Wide-field fundus photograph from neonatal ROP screening.
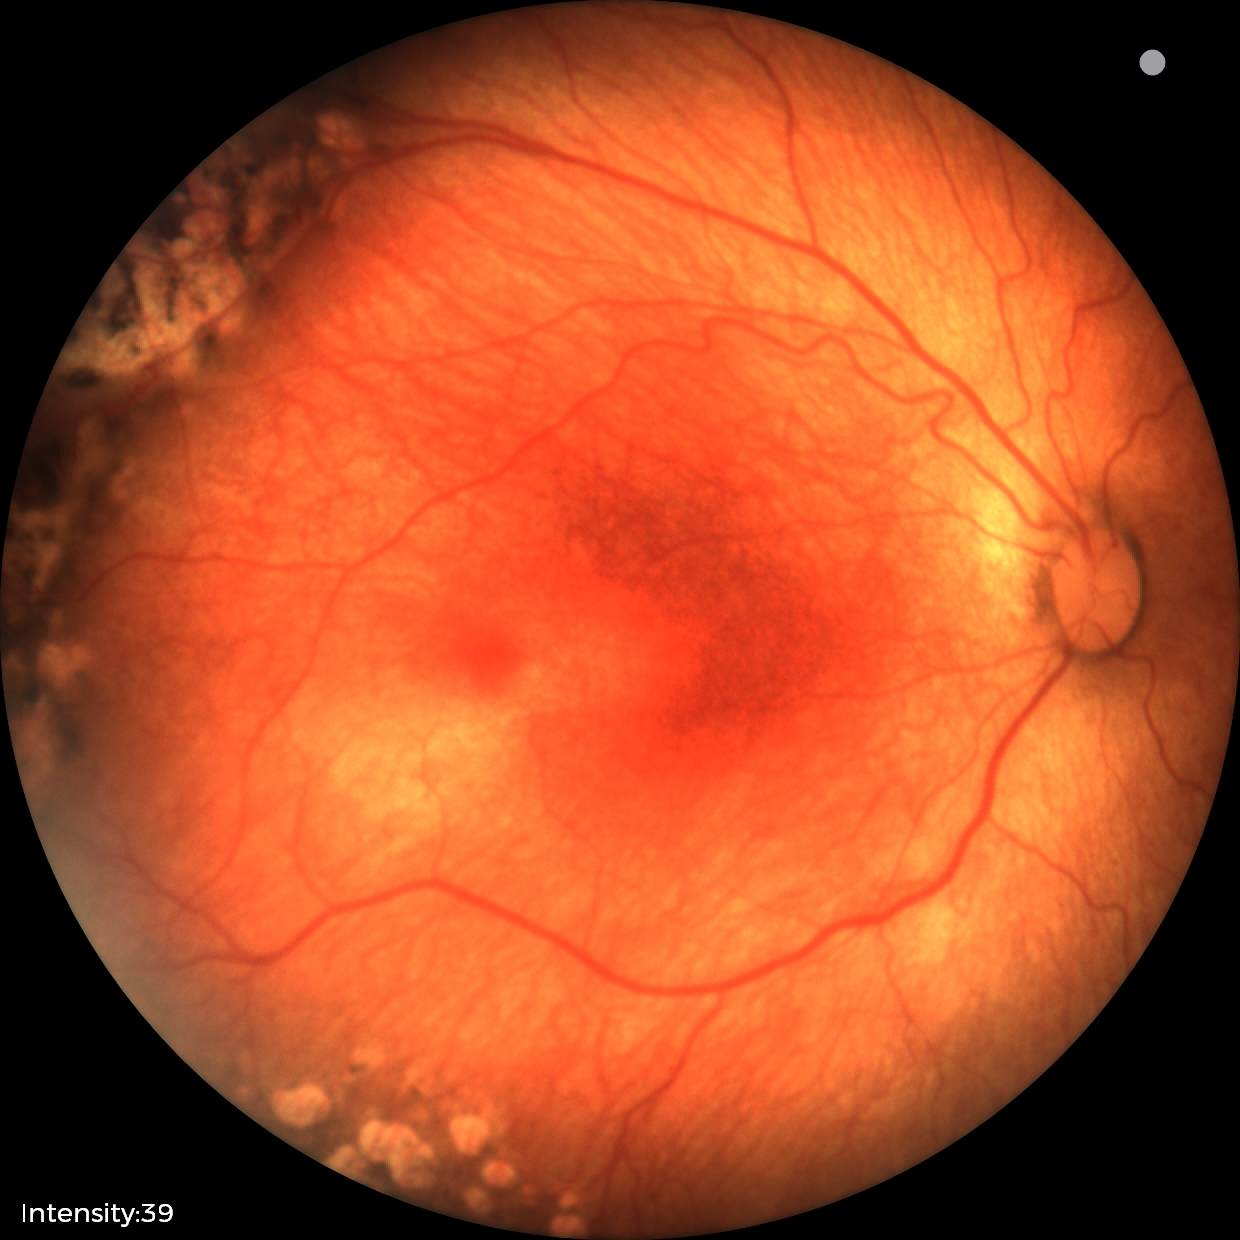 Screening examination consistent with status post ROP.